Diabetic retinopathy graded by the modified Davis classification: 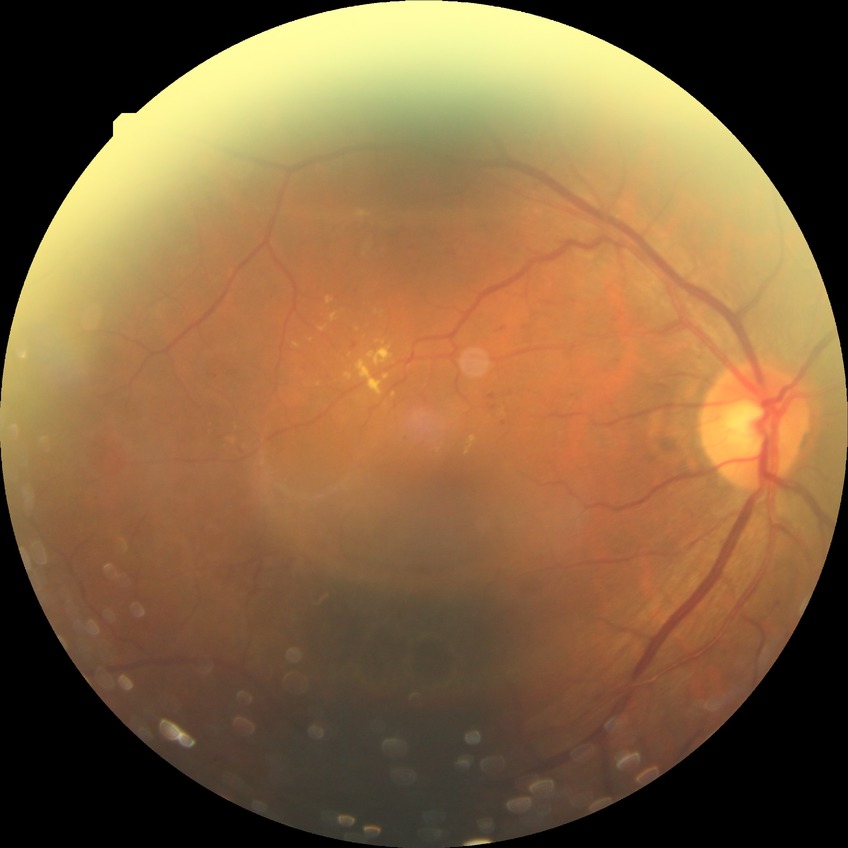 retinopathy stage: simple diabetic retinopathy